Modified Davis grading:
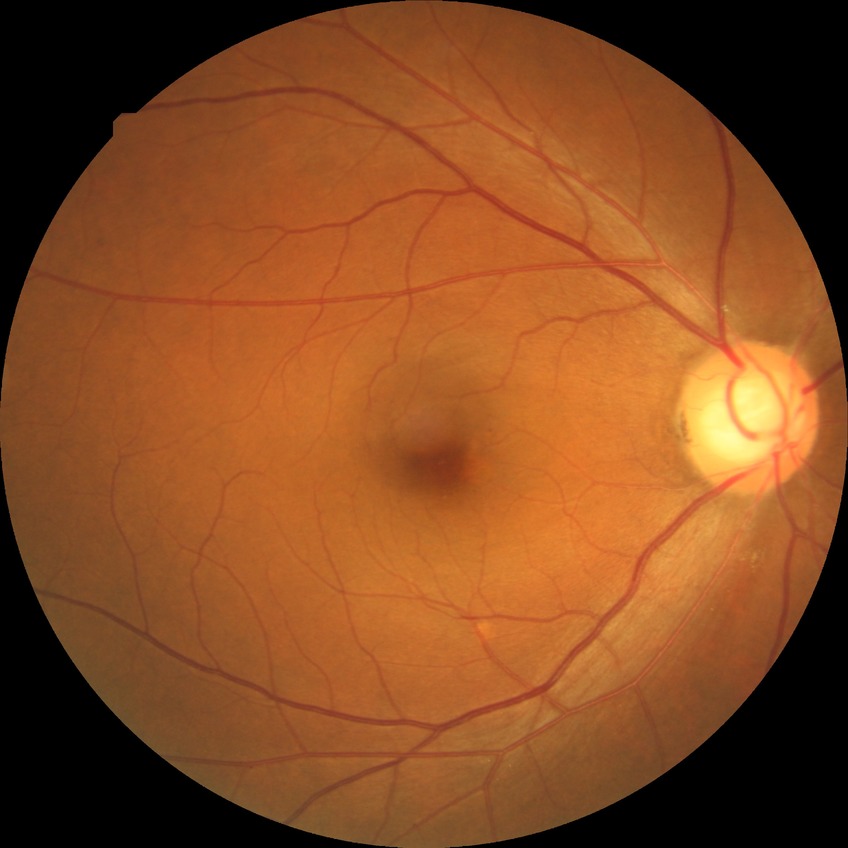 DR grade: SDR.